NIDEK AFC-230 · image size 848x848 · modified Davis classification · posterior pole color fundus photograph · nonmydriatic.
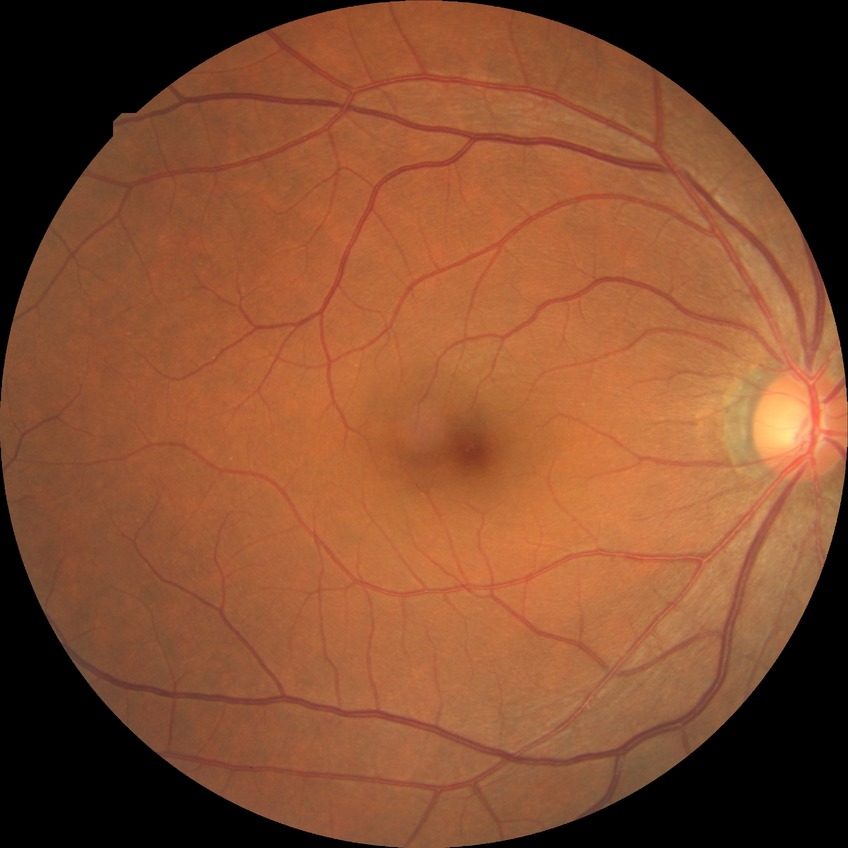

  davis_grade: simple diabetic retinopathy